Wide-field fundus photograph from neonatal ROP screening · camera: Natus RetCam Envision (130° FOV).
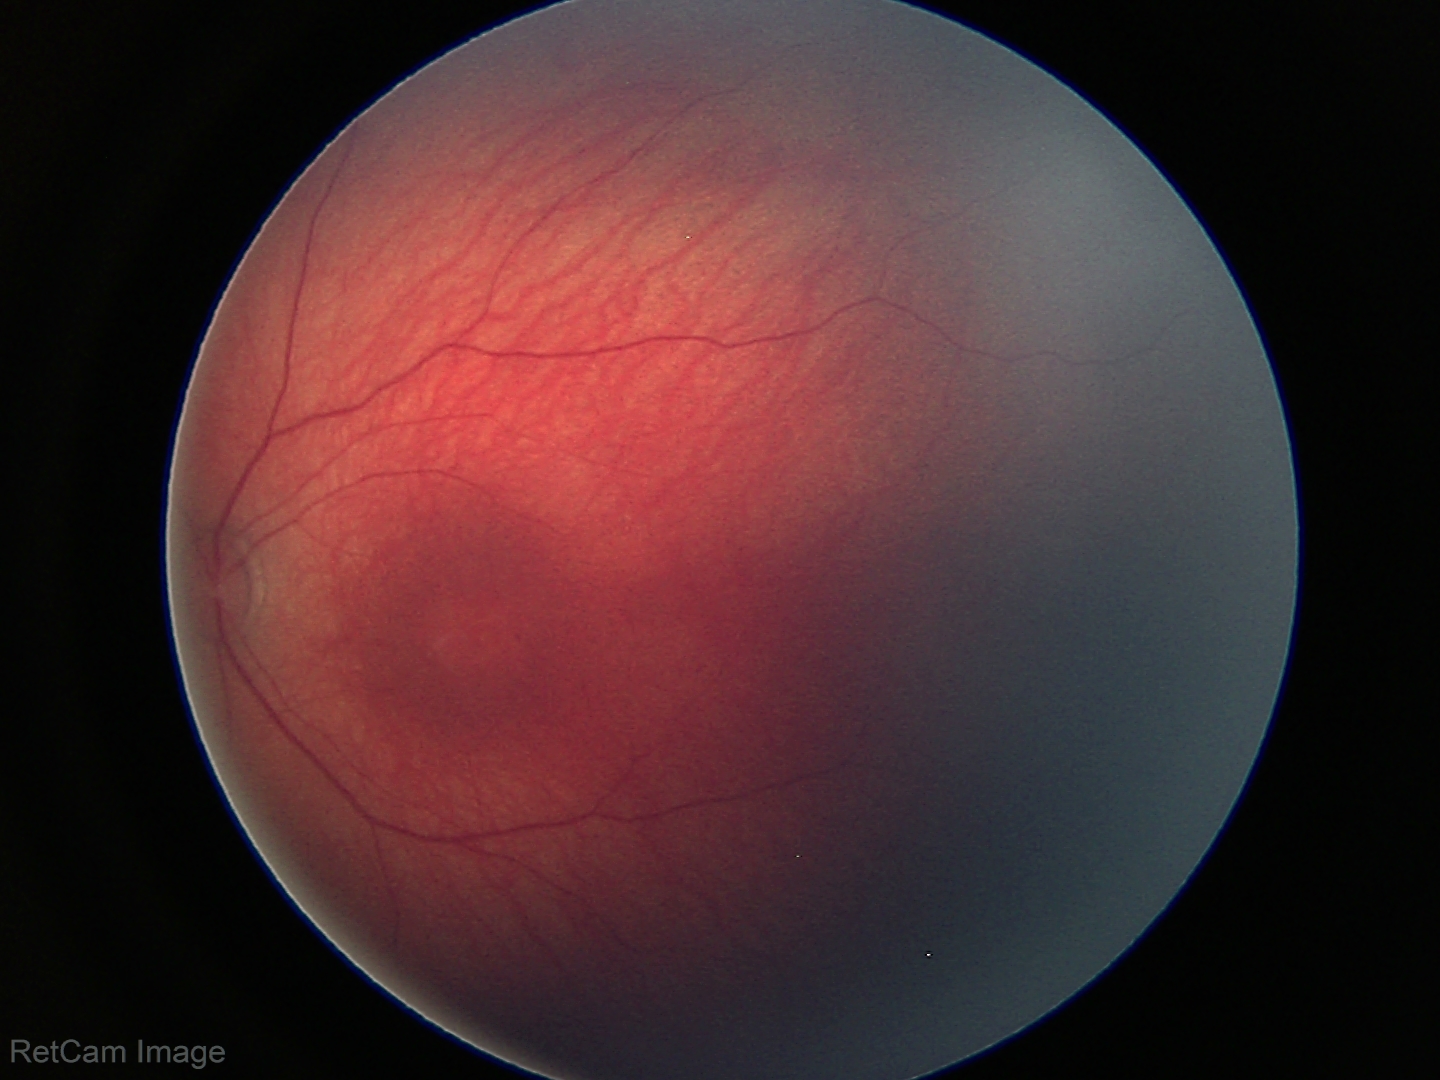

Examination with physiological retinal findings.